Graded on the modified Davis scale:
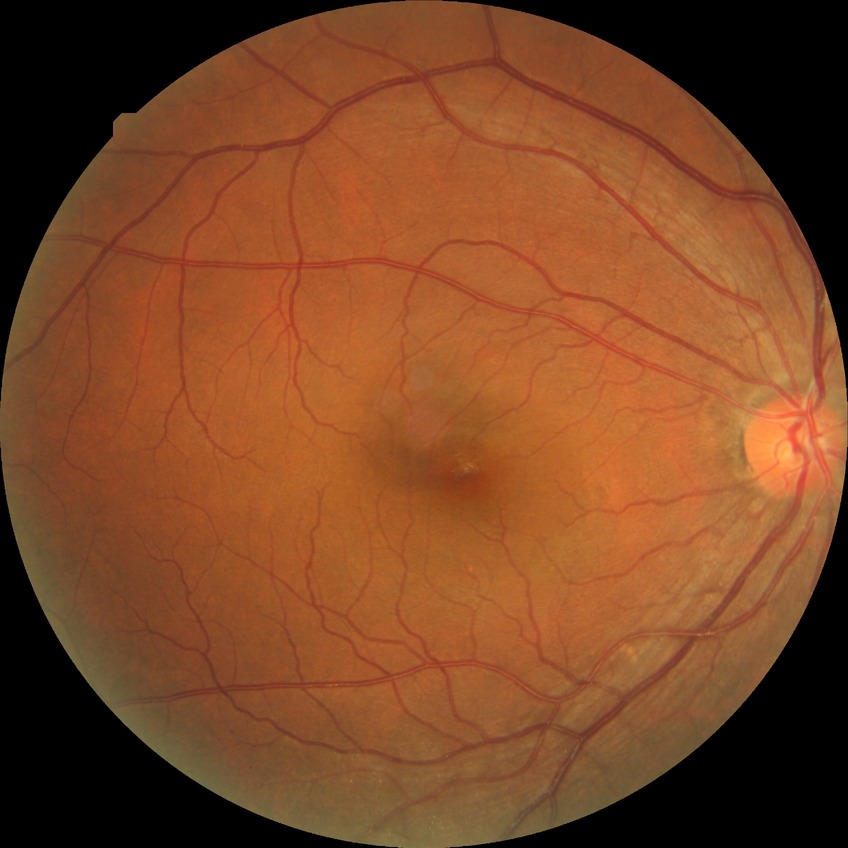
Diabetic retinopathy (DR): SDR (simple diabetic retinopathy).